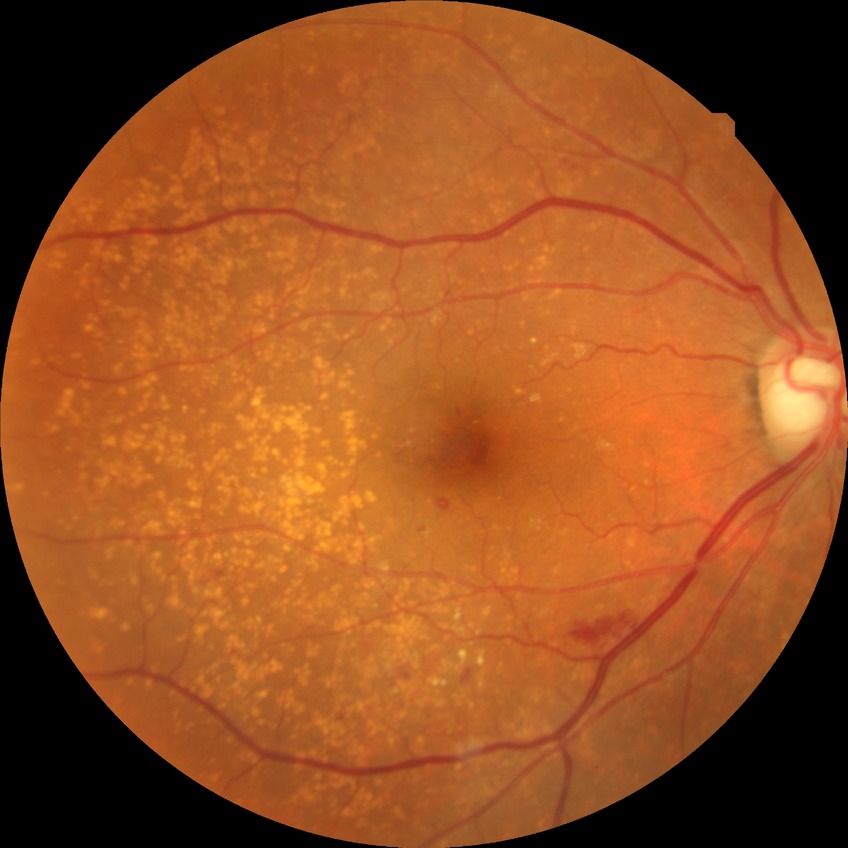

davis_grade: SDR